1440x1080. Infant wide-field retinal image
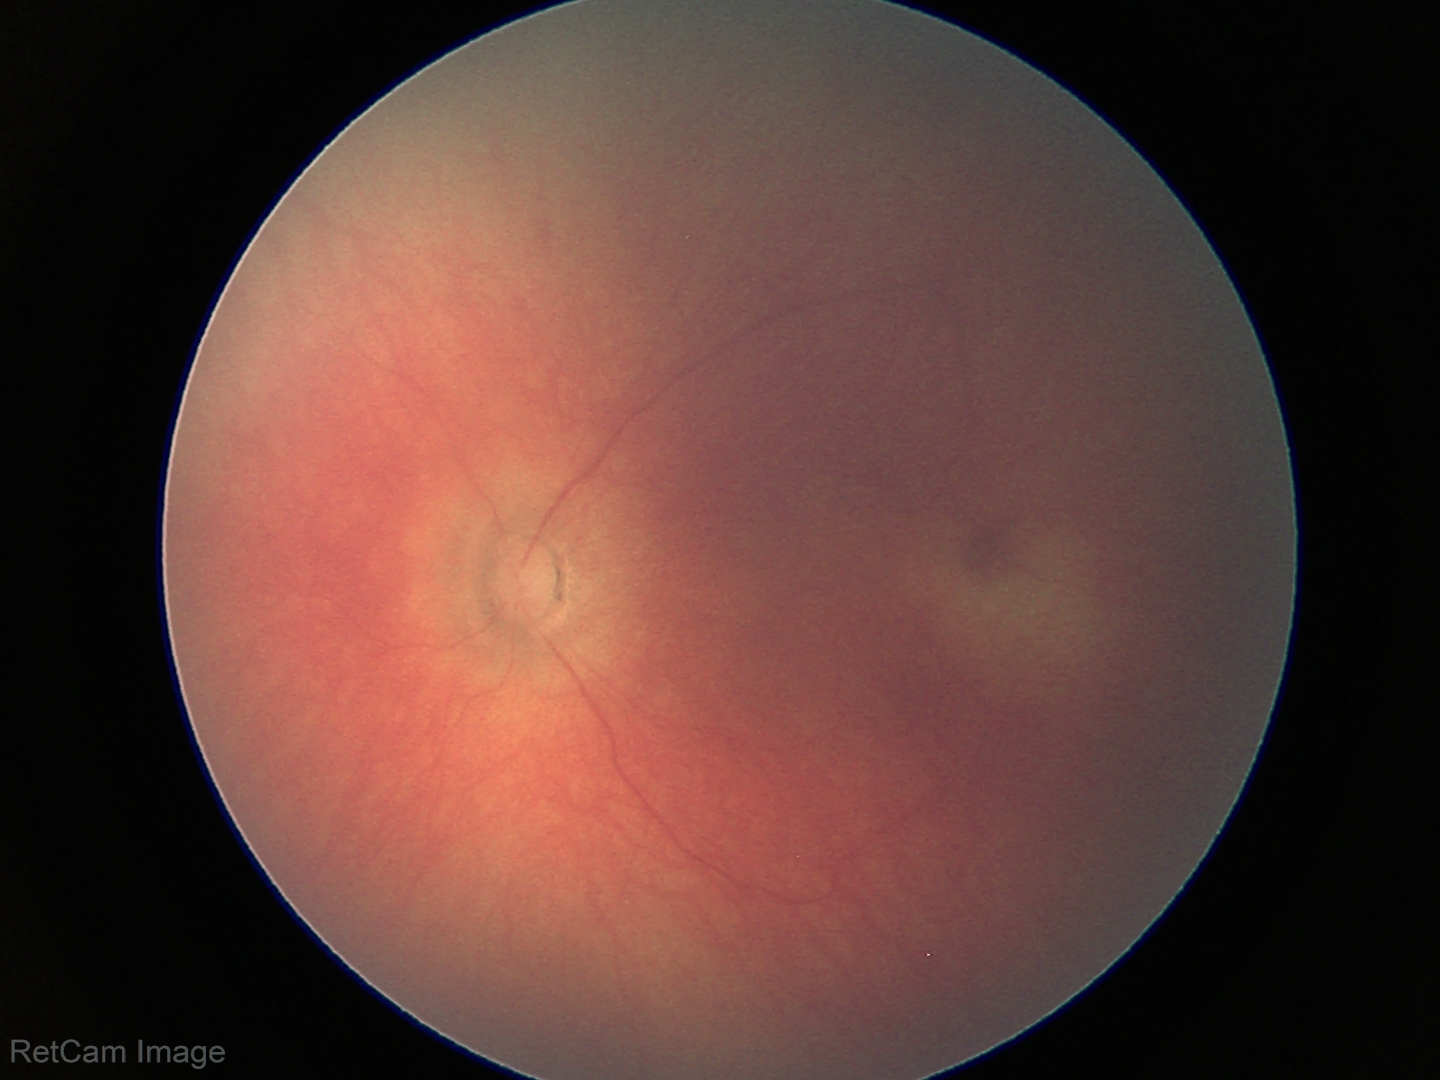
Screening: physiological appearance with no retinal pathology.